45-degree field of view. 2048 x 1536 pixels. Color fundus image
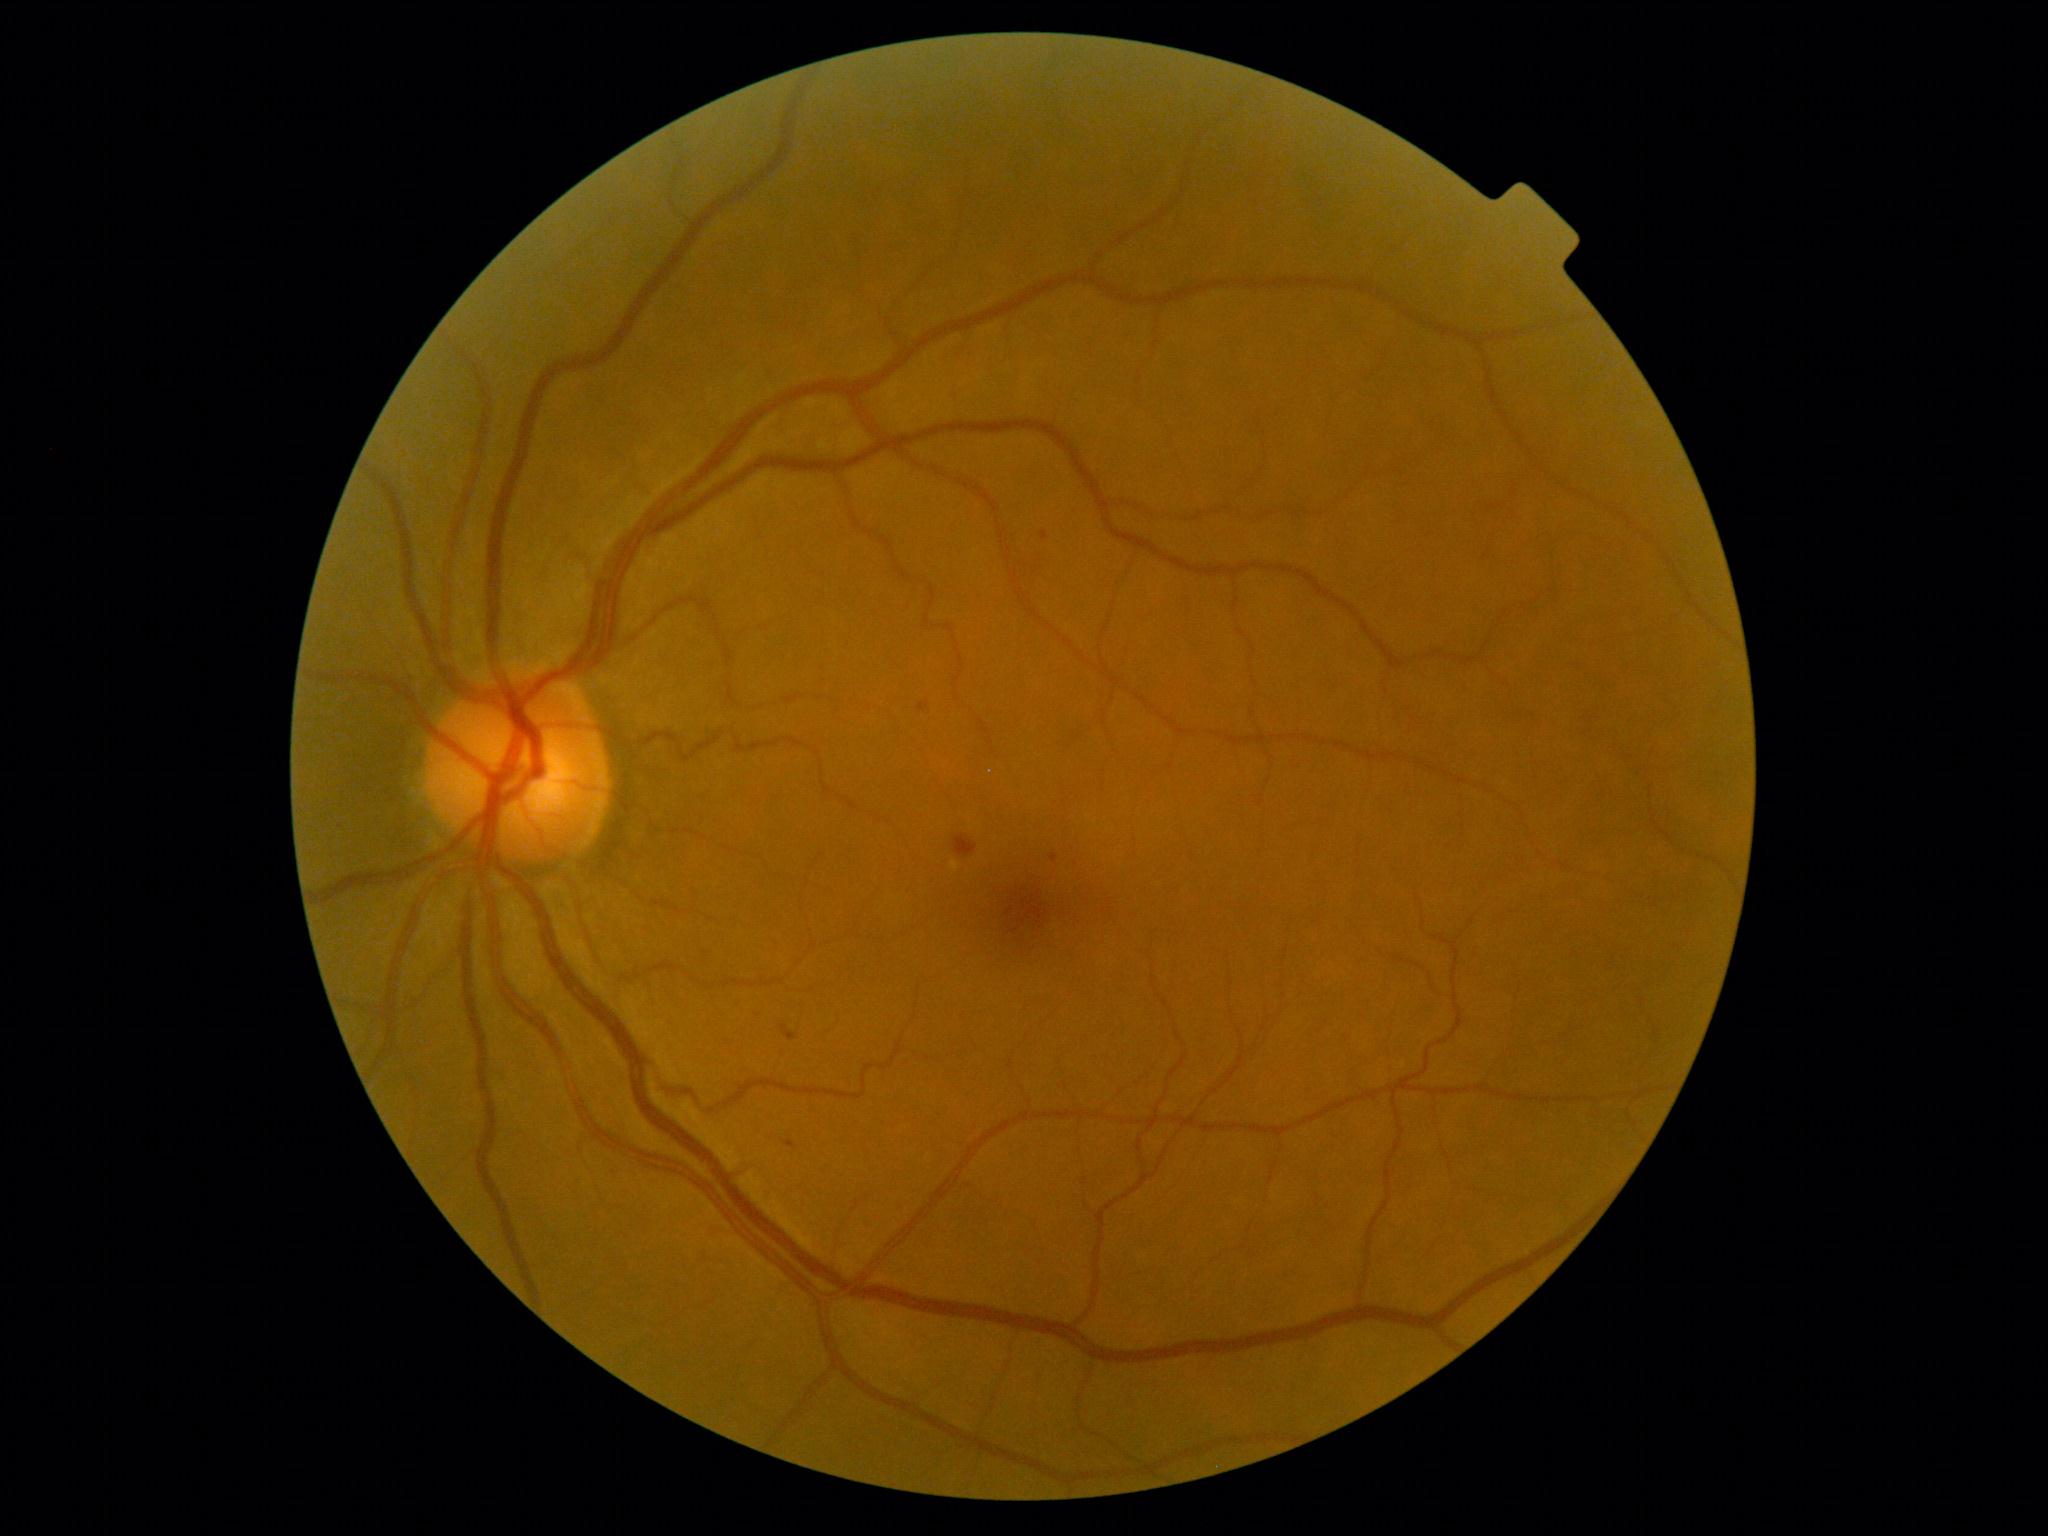

Retinopathy is grade 2 (moderate NPDR).